Phoenix ICON, 100° FOV · 1240x1240px · Phoenix ICON wide-field infant fundus image:
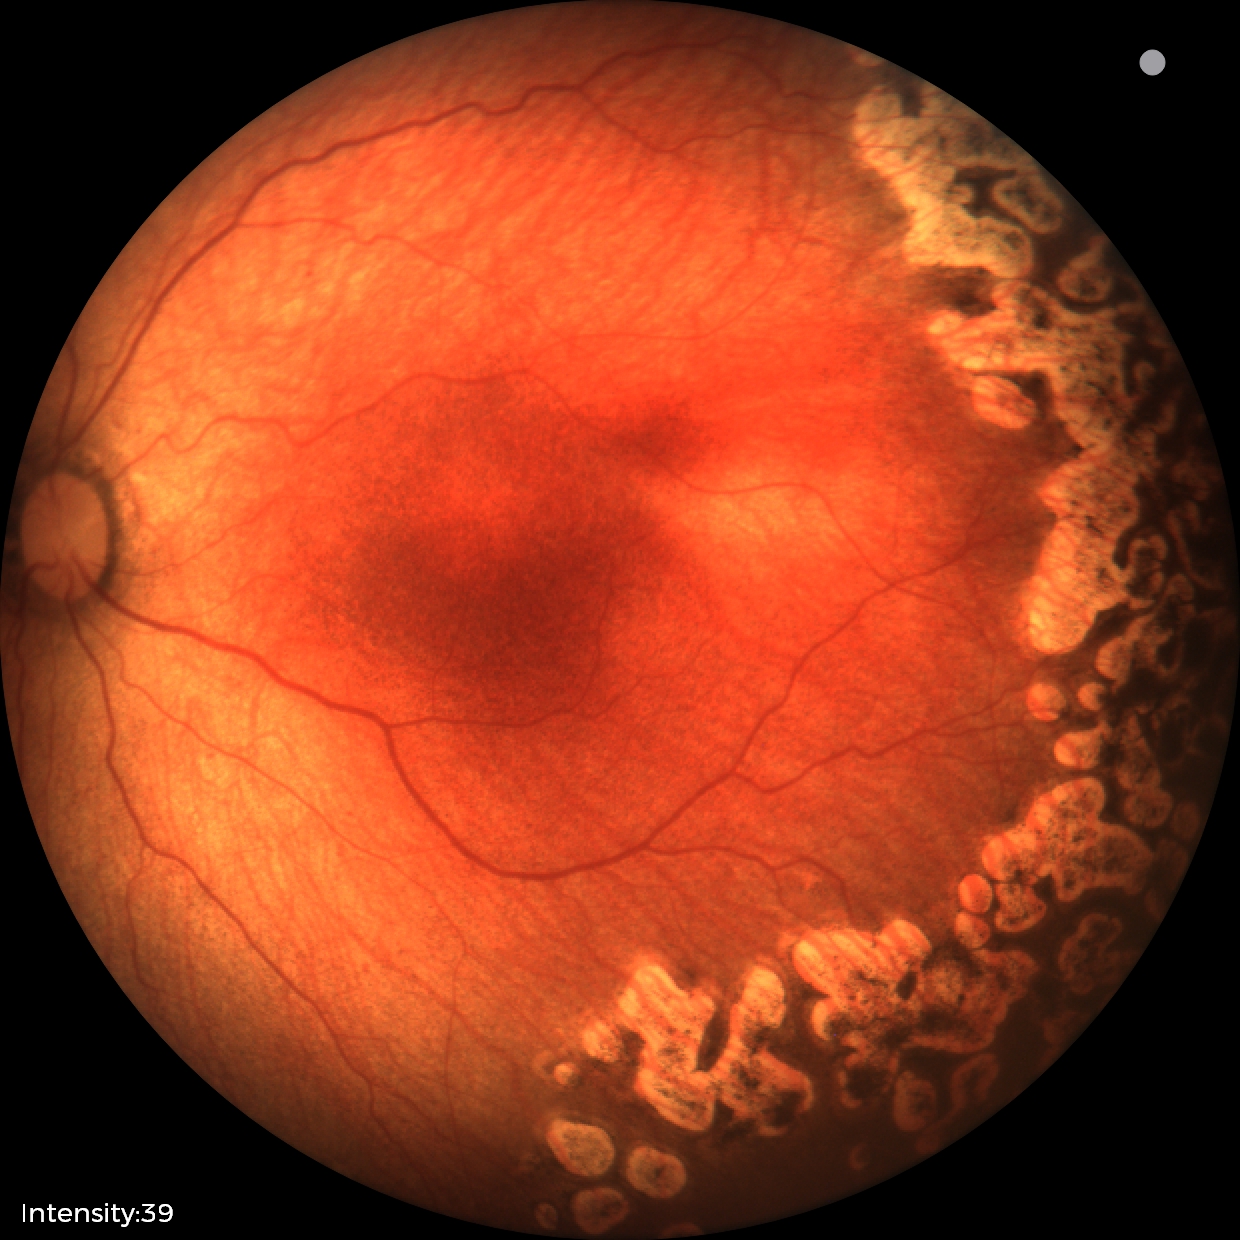
Plus disease absent.
Diagnosis from this screening exam: status post retinopathy of prematurity.